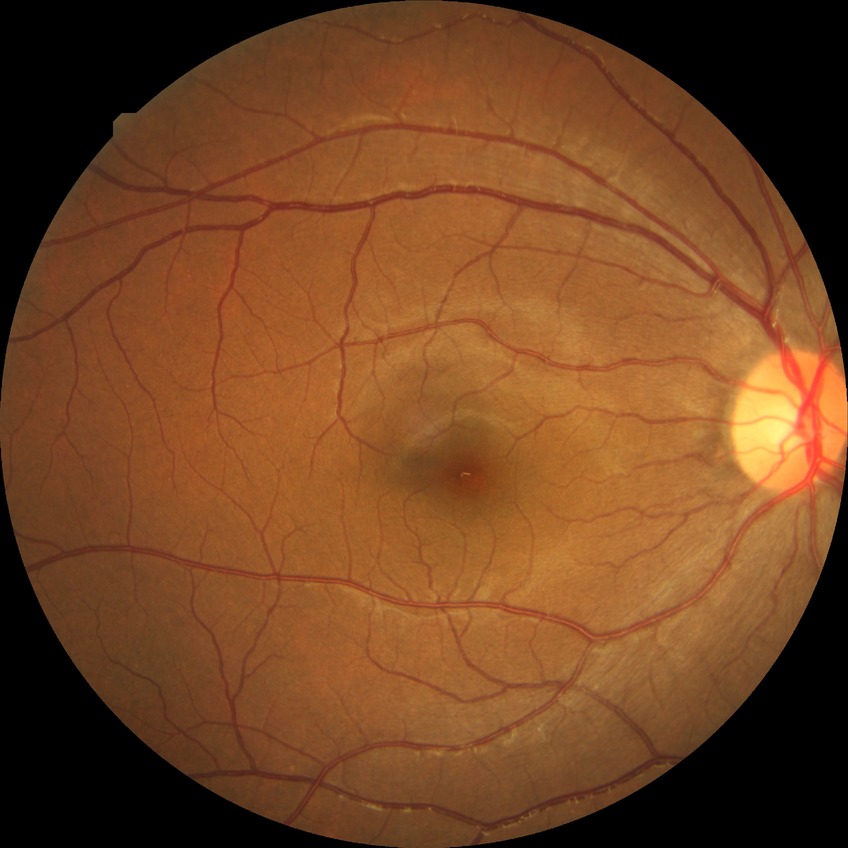

Assessment:
* diabetic retinopathy (DR) — NDR (no diabetic retinopathy)